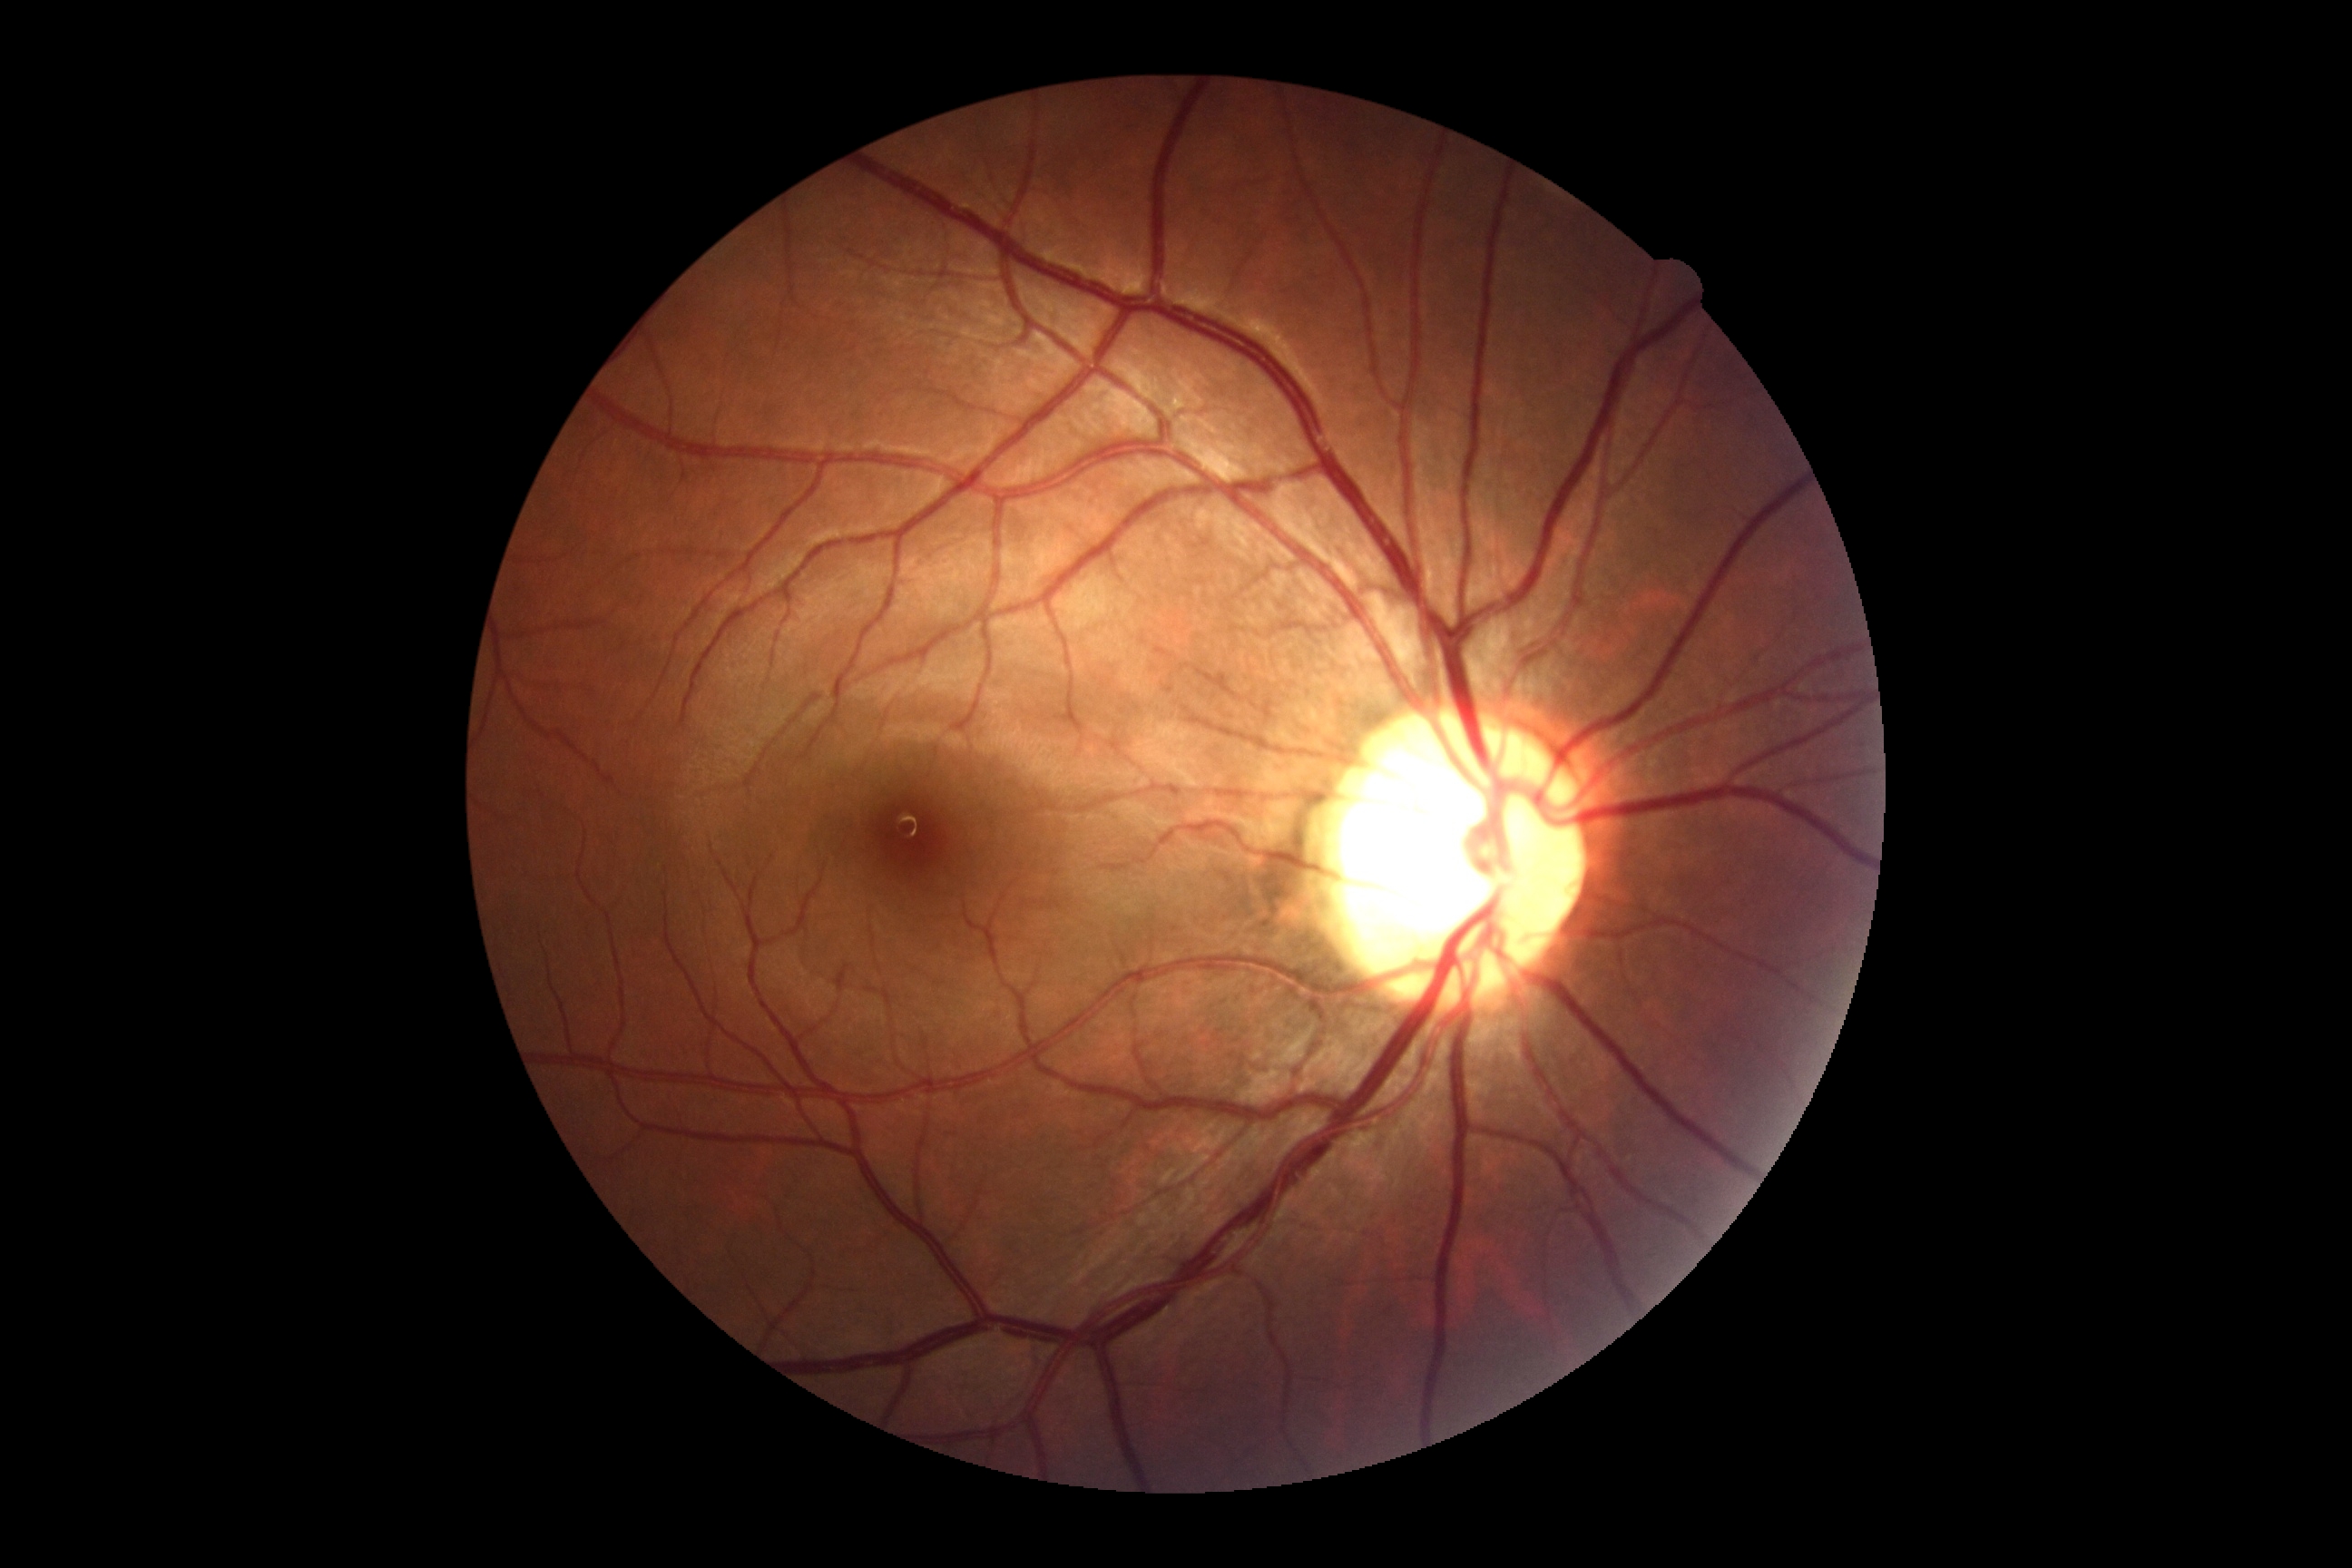
Diabetic retinopathy (DR) is grade 0 (no apparent retinopathy).